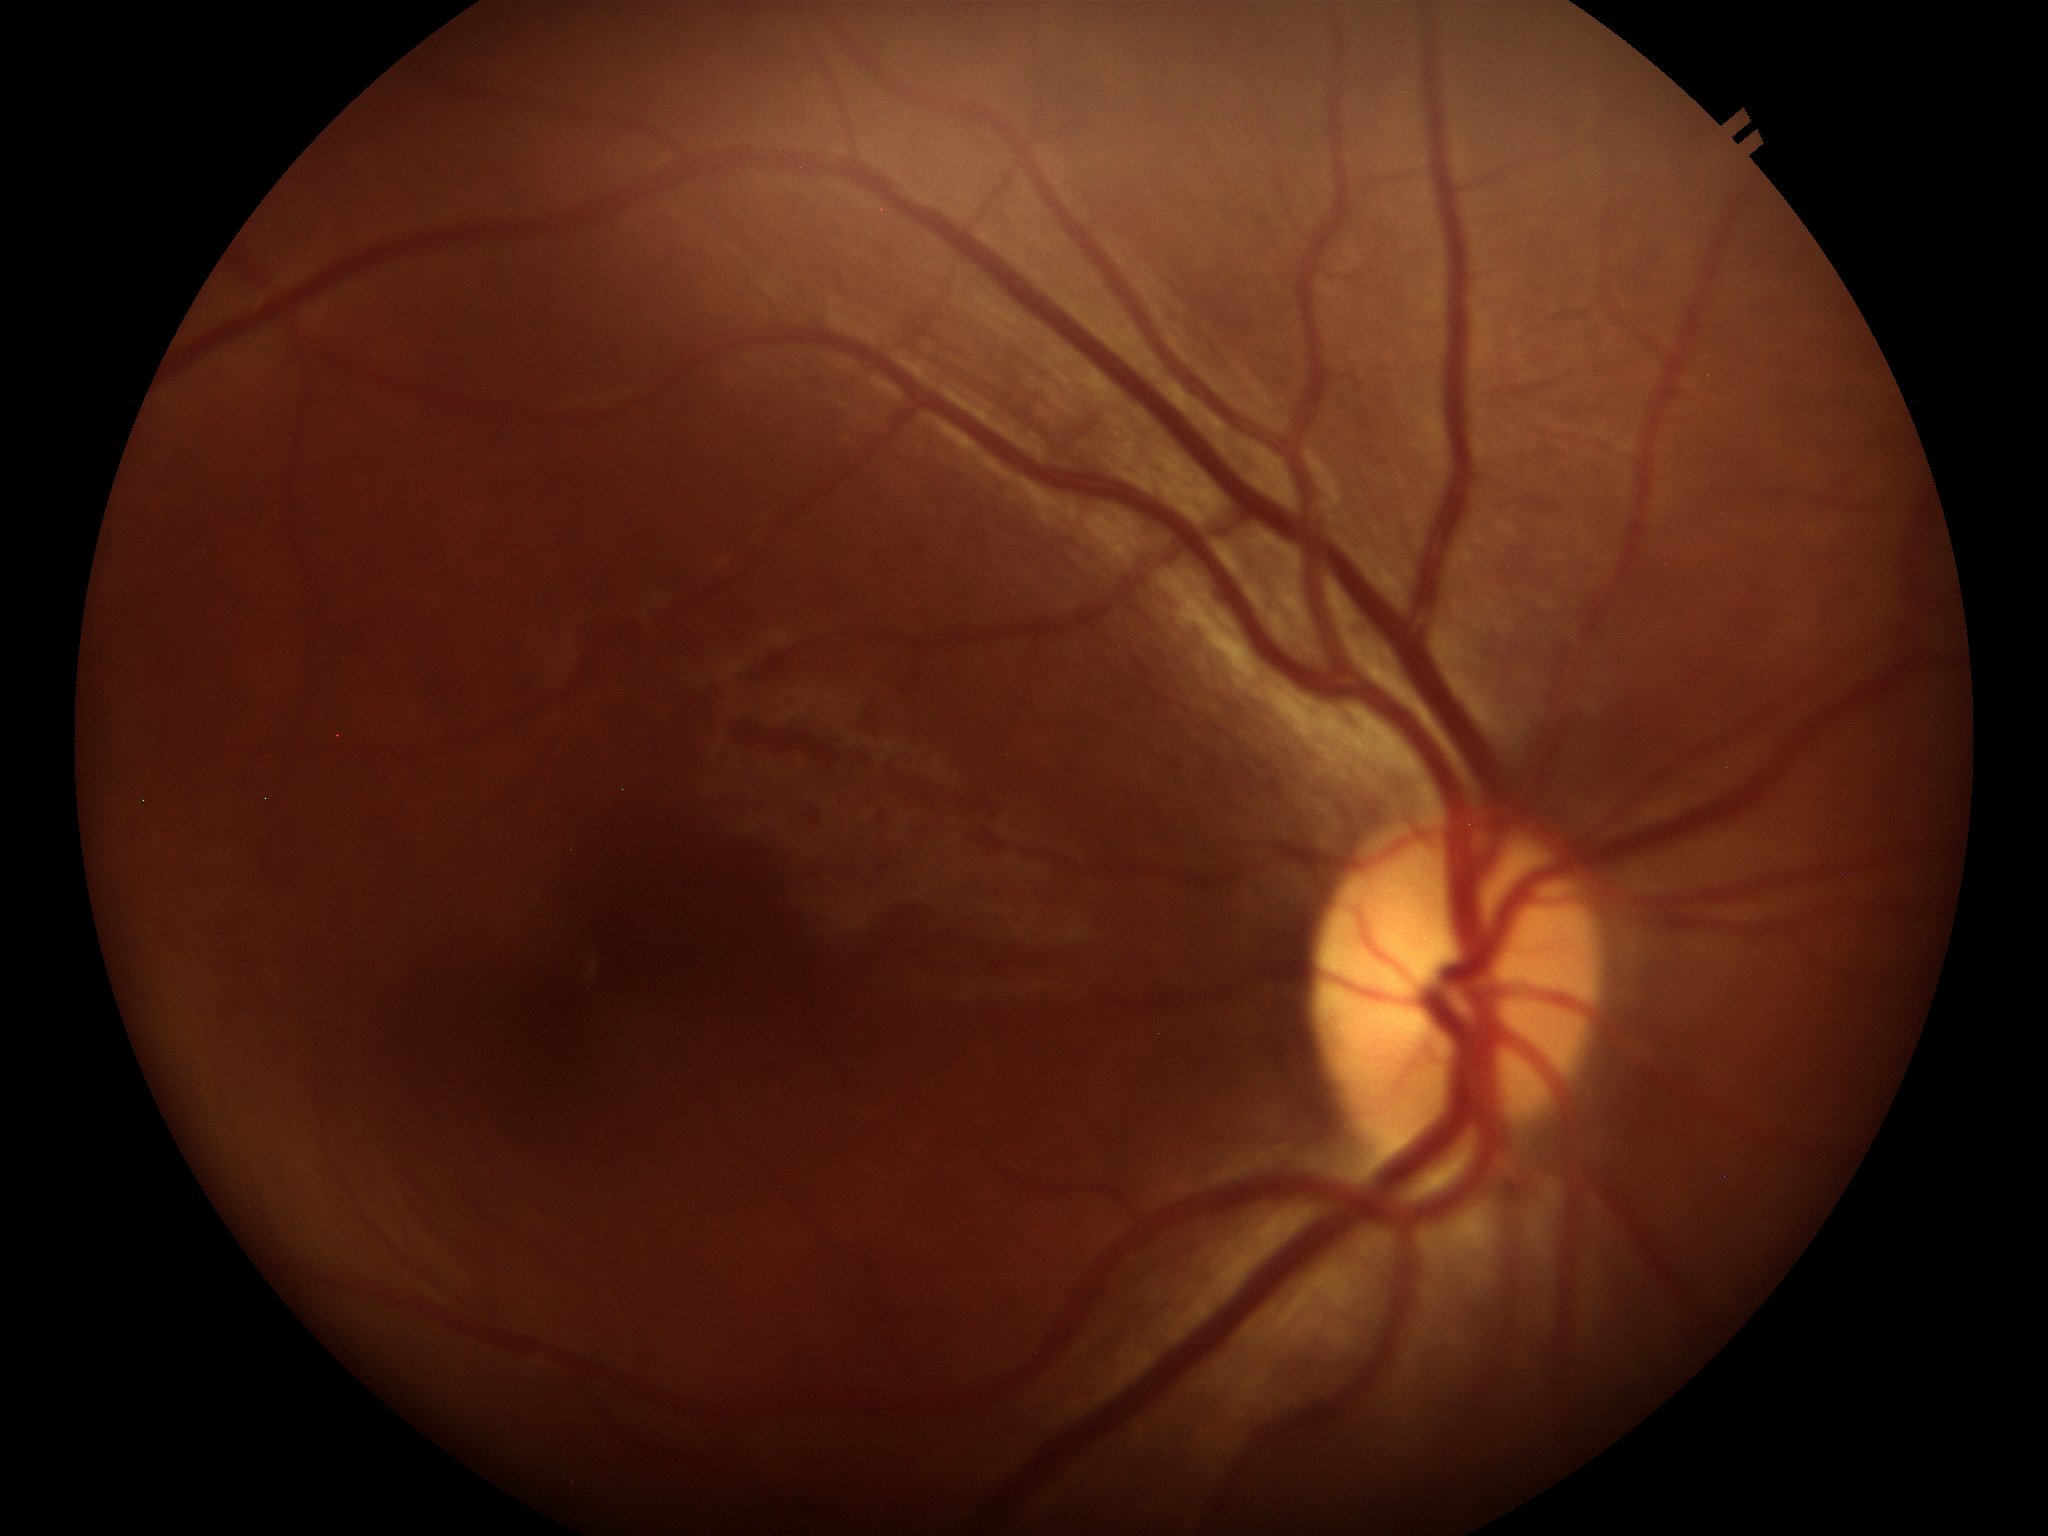
Glaucoma screening impression: negative (all 5 graders called normal). Vertical C/D ratio is 0.47.